Image size 2089x1764:
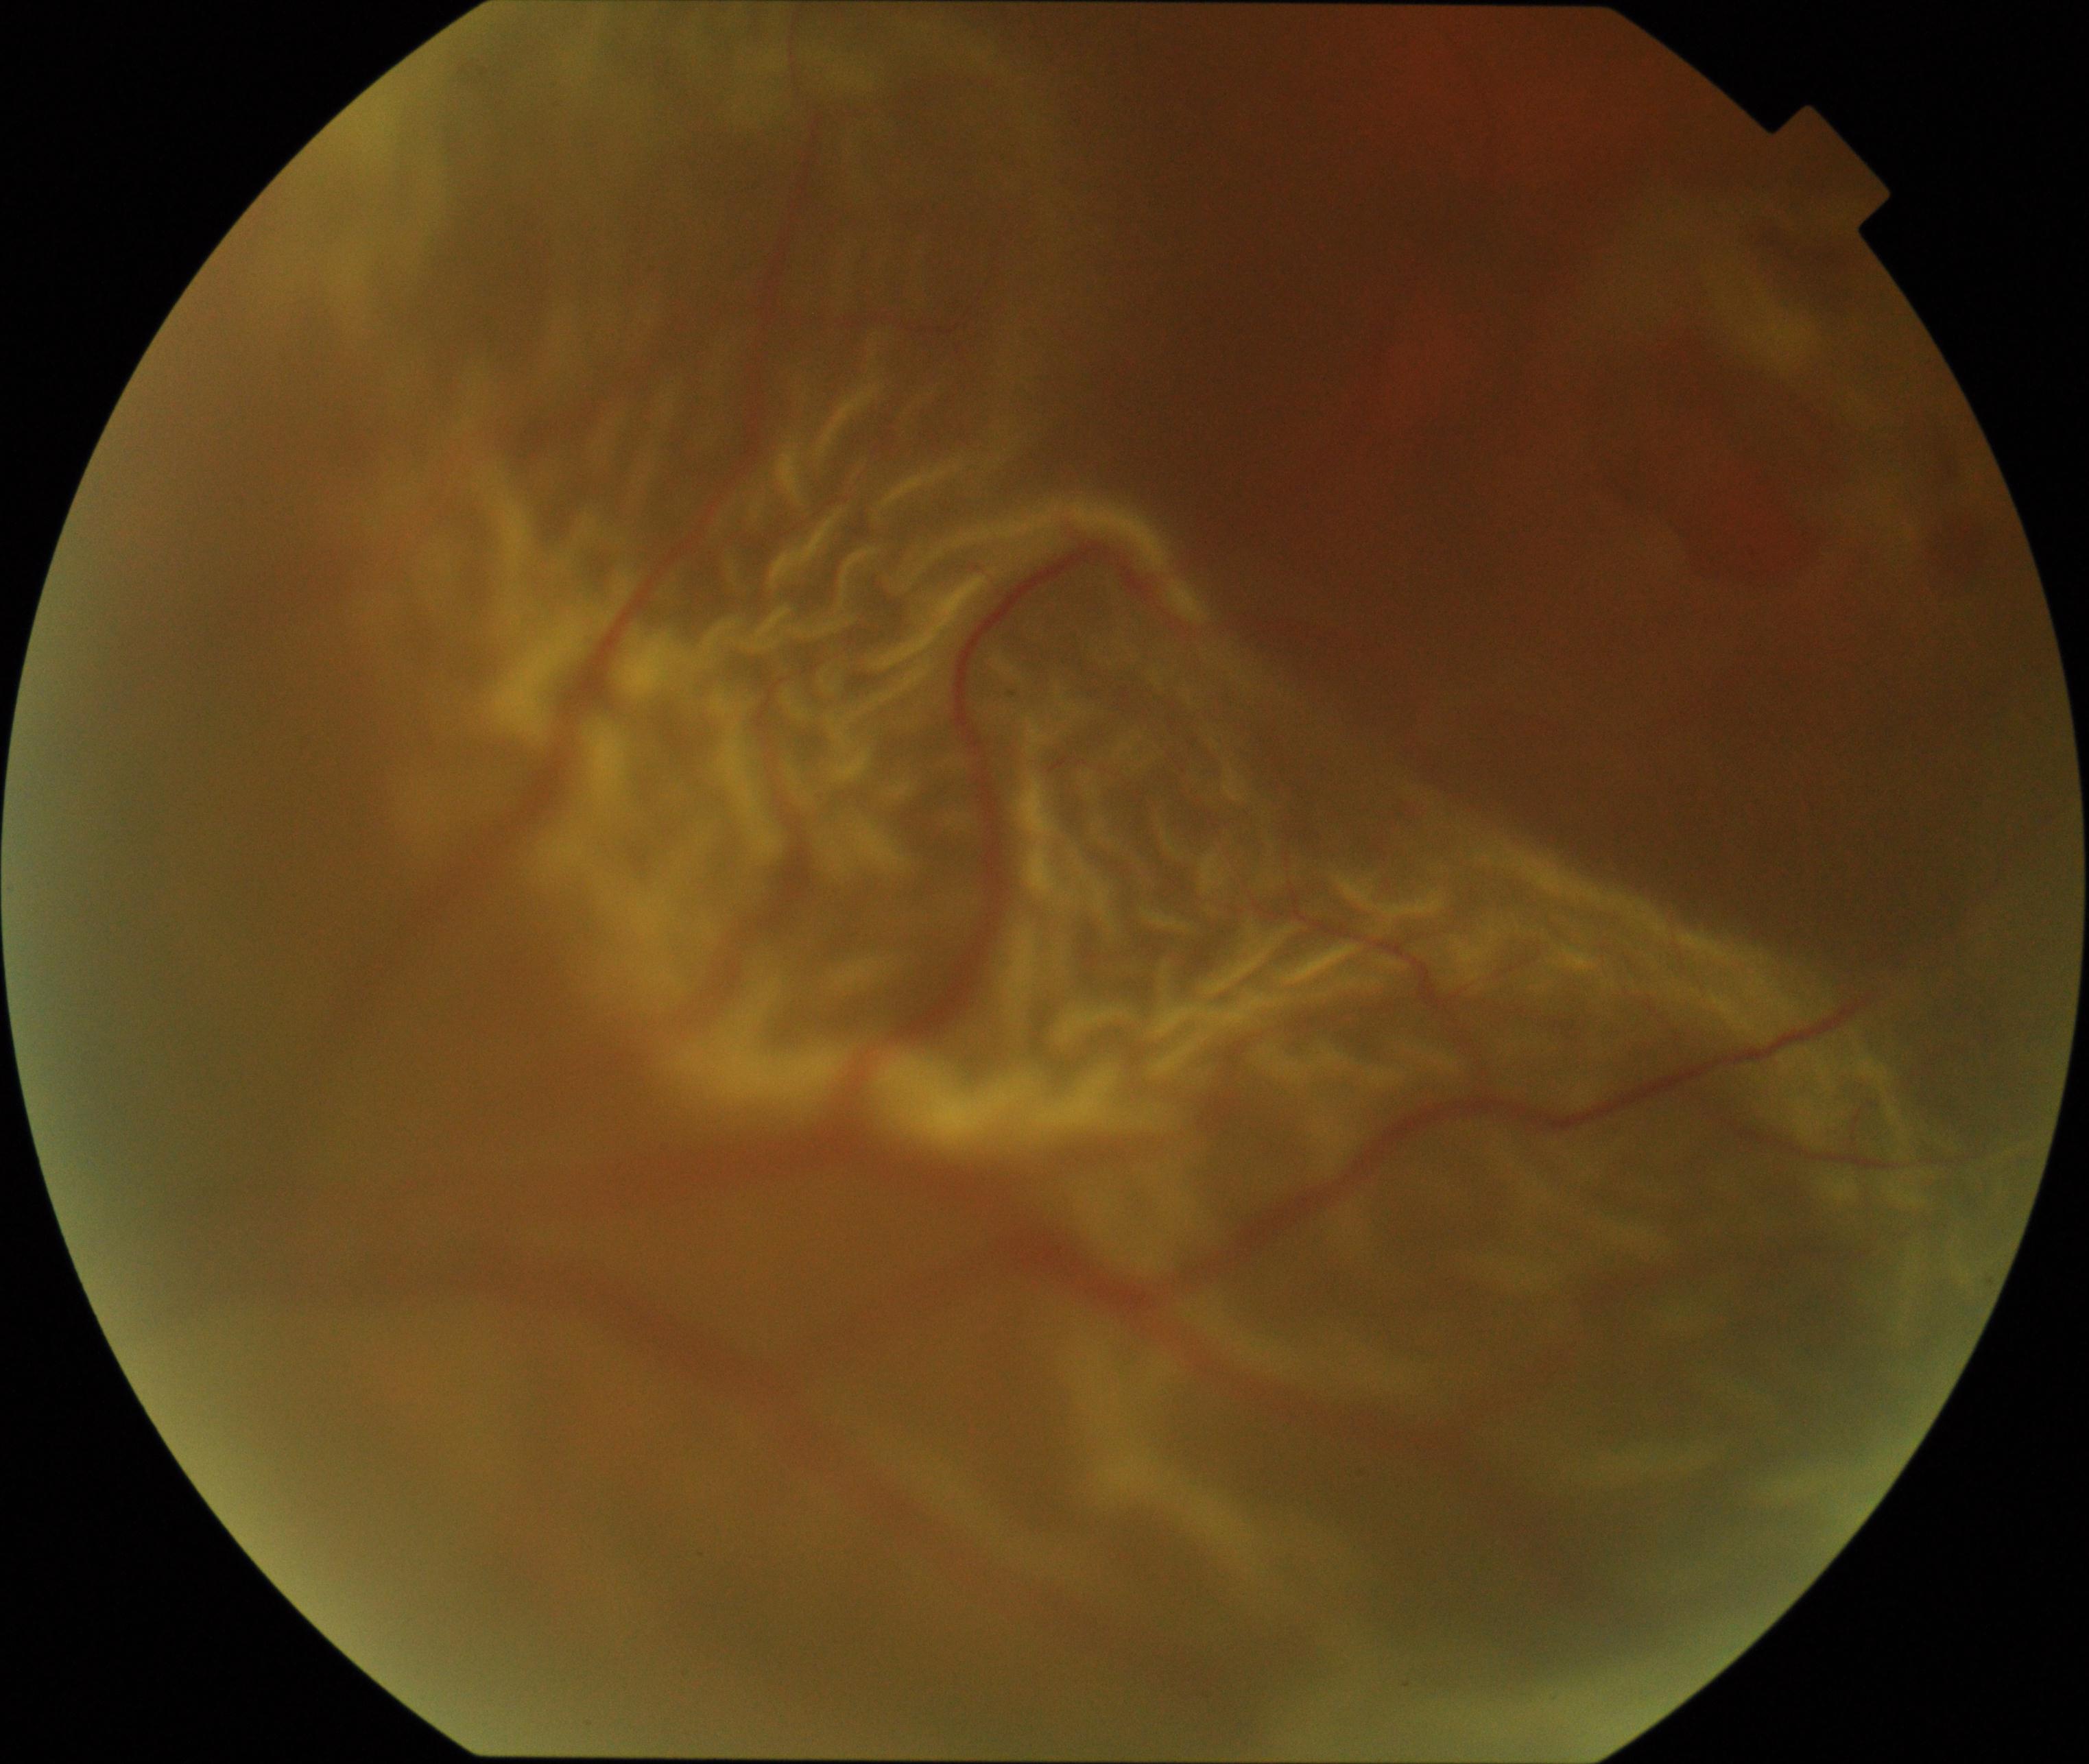 Retinal fundus photograph demonstrating rhegmatogenous retinal detachment.